Color fundus image, 45° field of view.
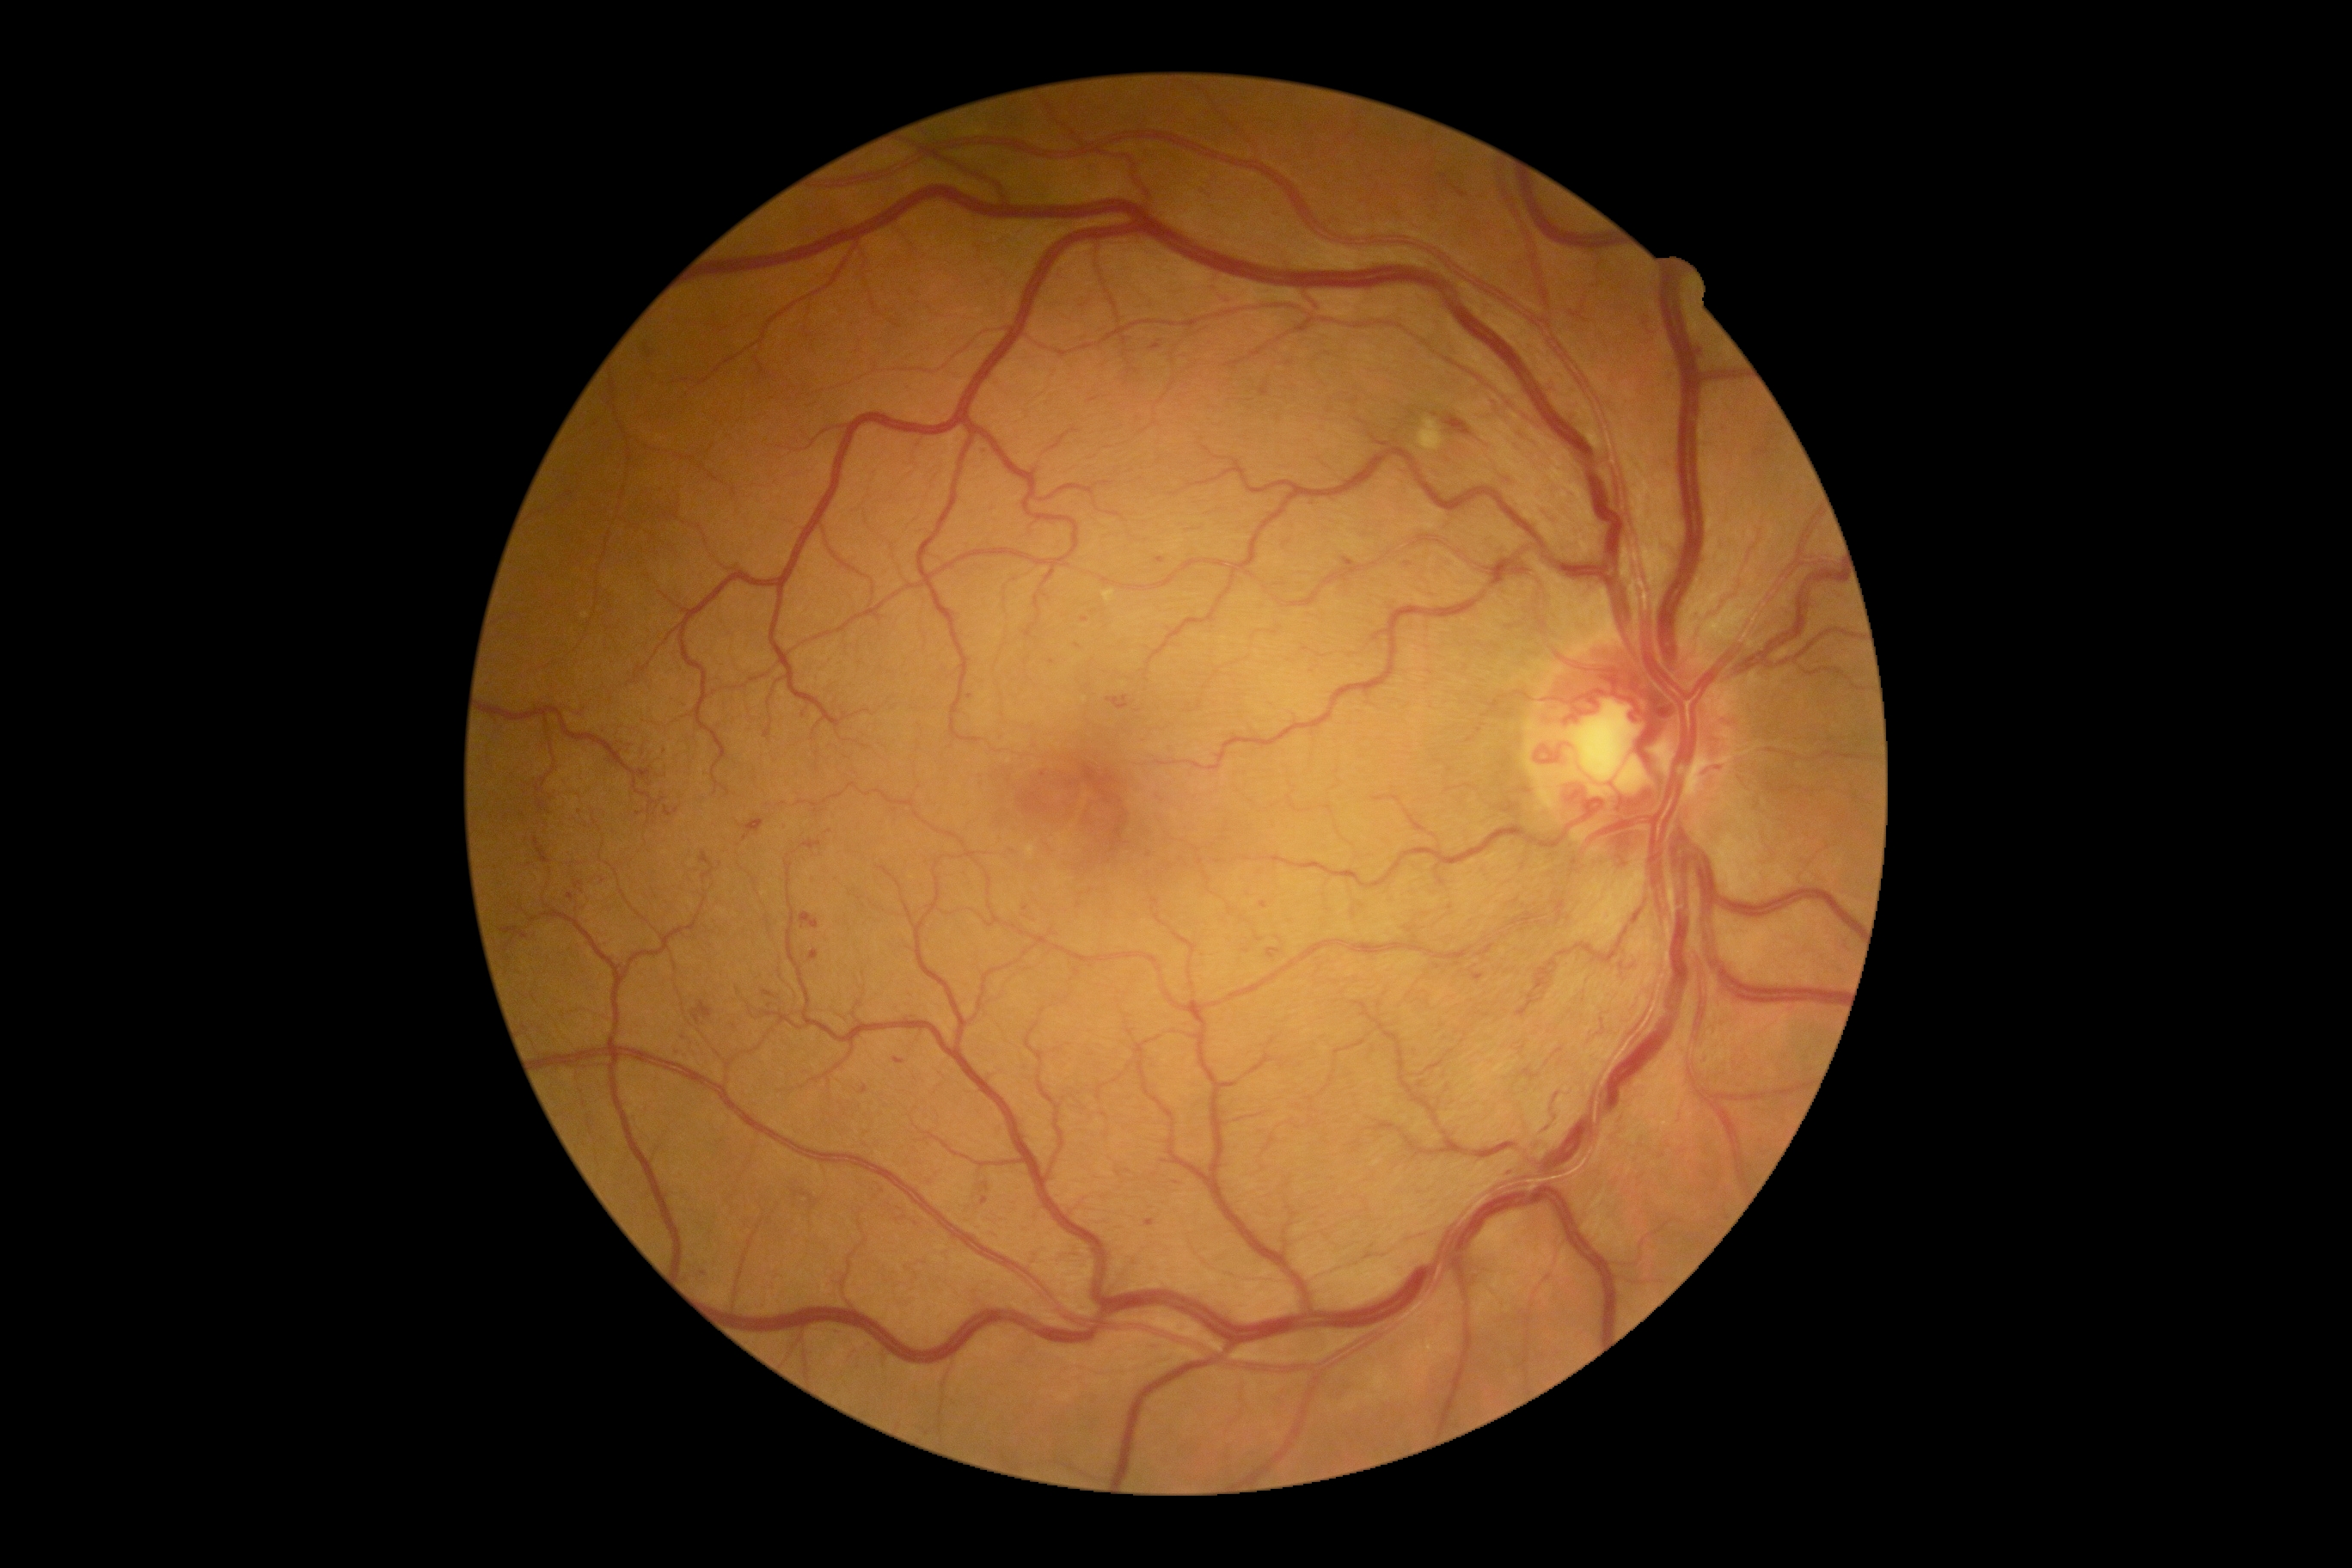 DR severity = grade 3 (severe NPDR).